Fundus photo · 2352x1568px · 45-degree field of view.
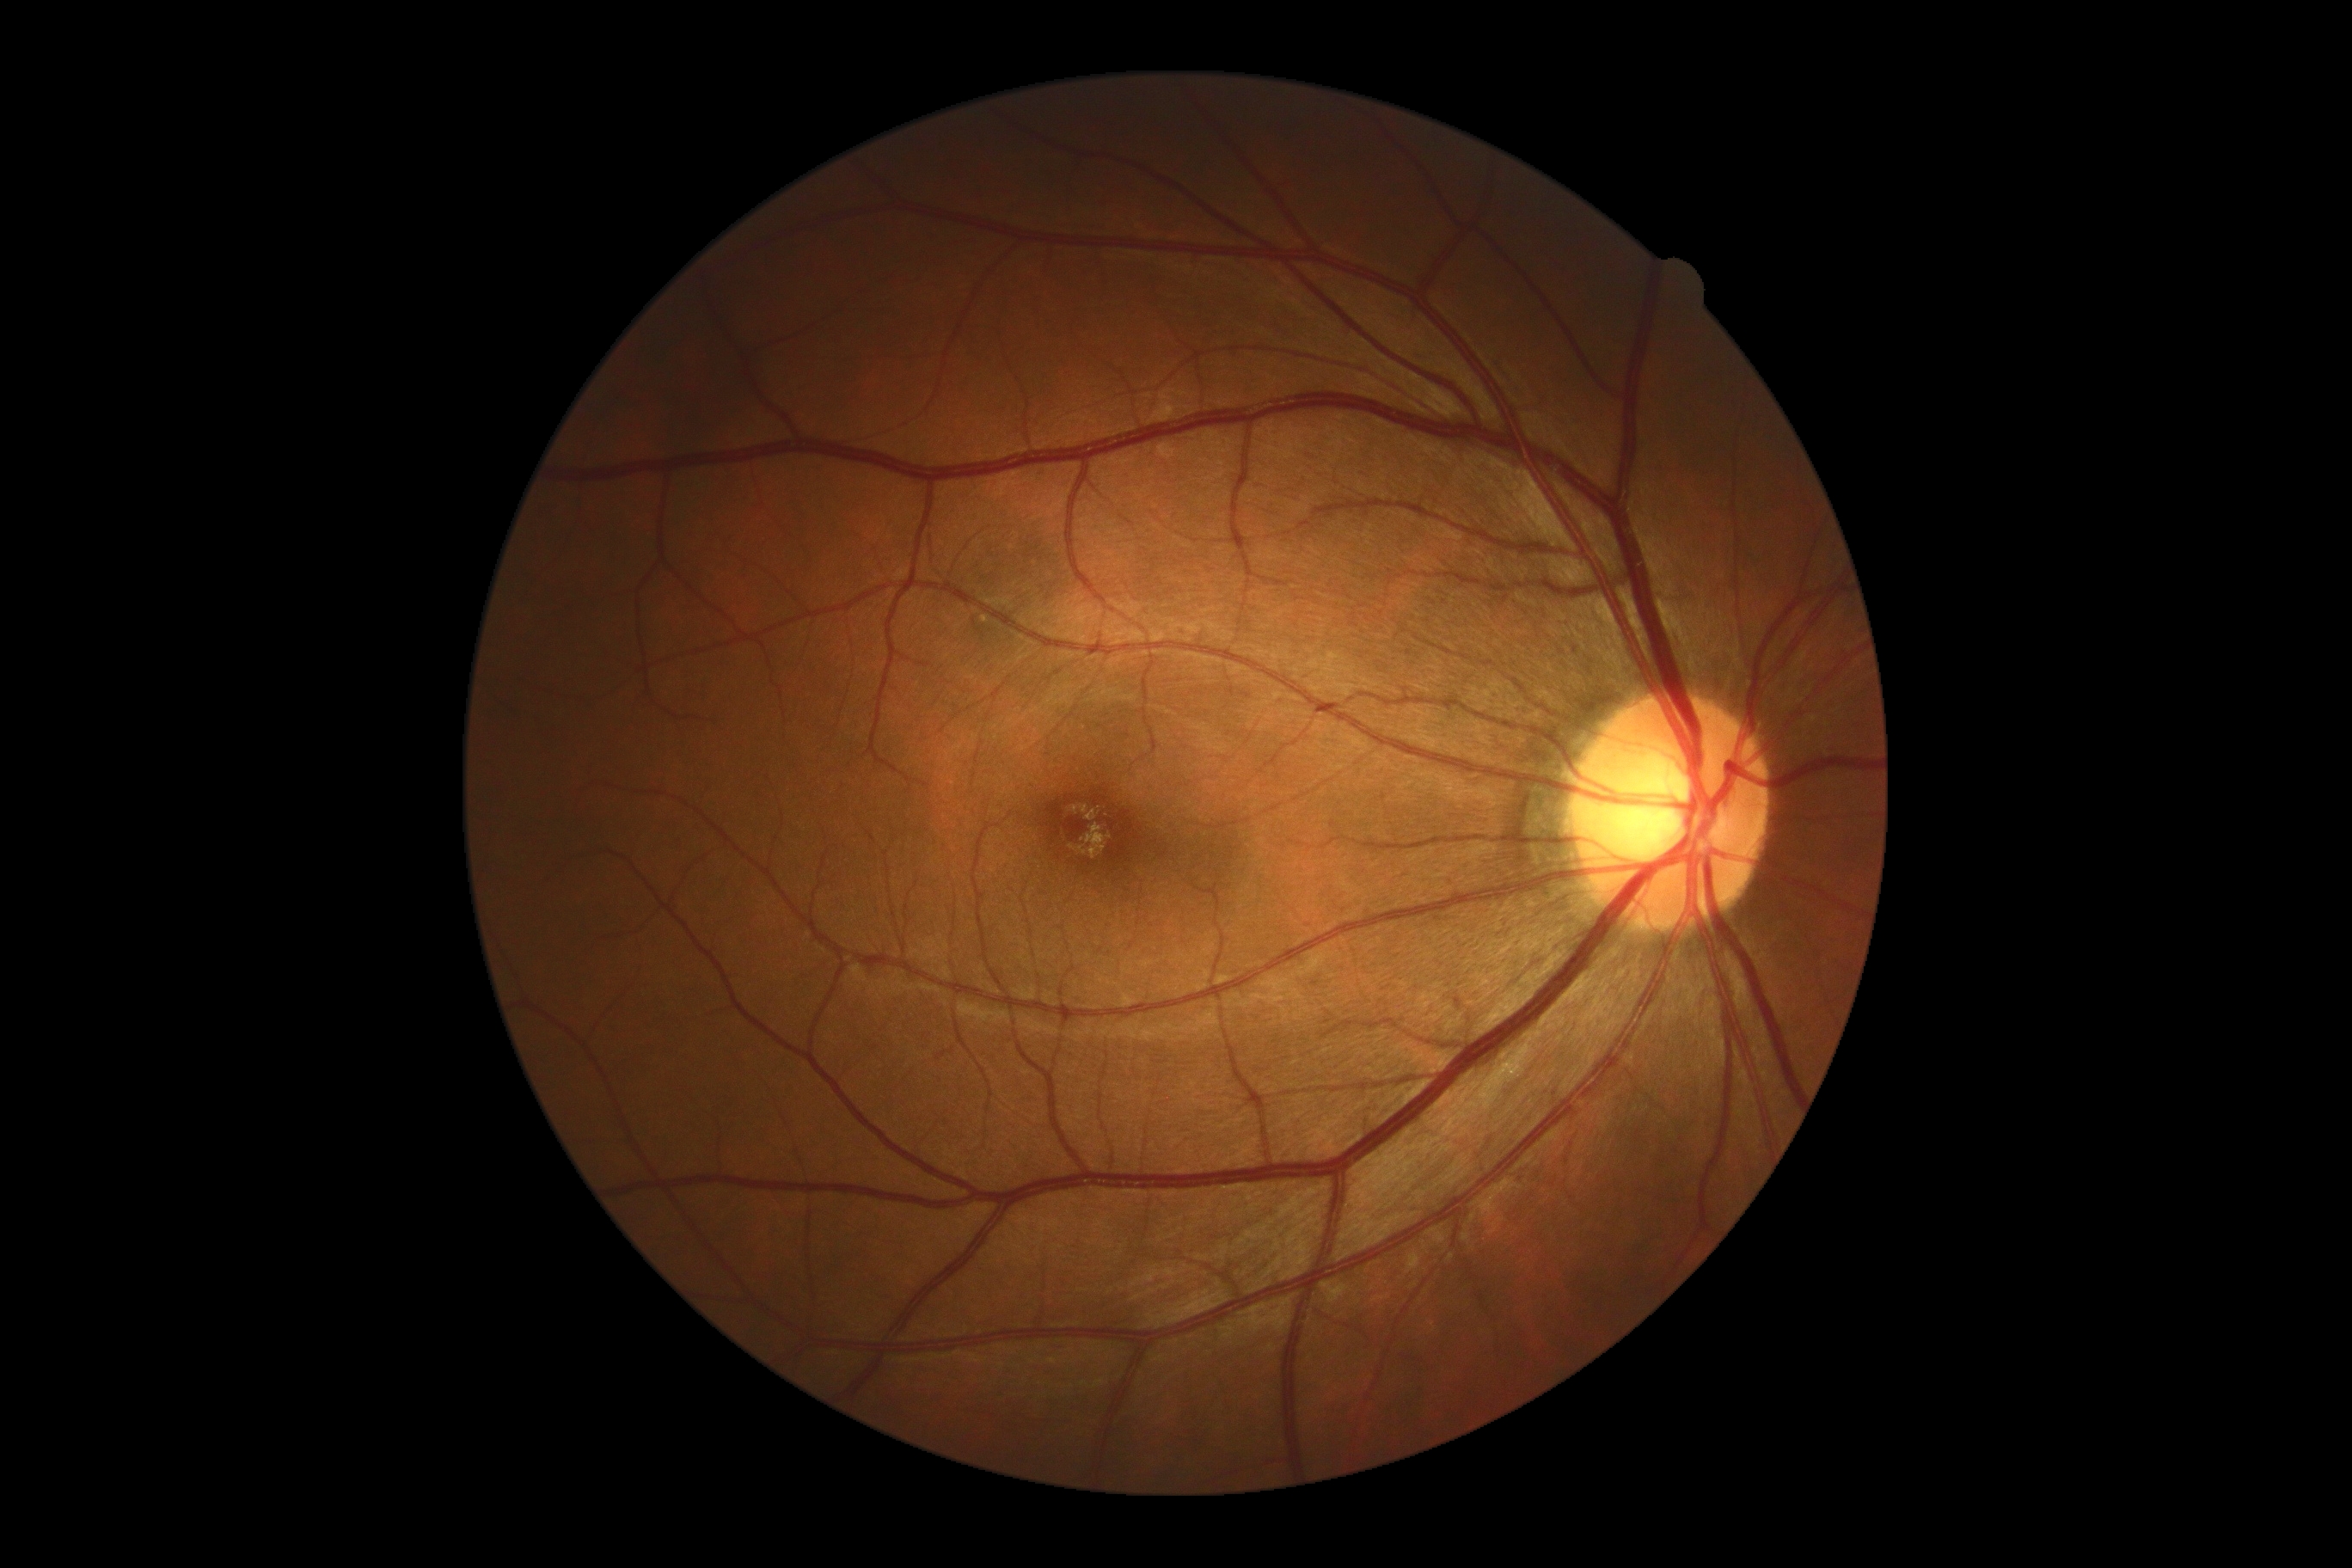 diabetic retinopathy (DR) = 0/4.